45-degree field of view; retinal fundus photograph; 2352 x 1568 pixels: 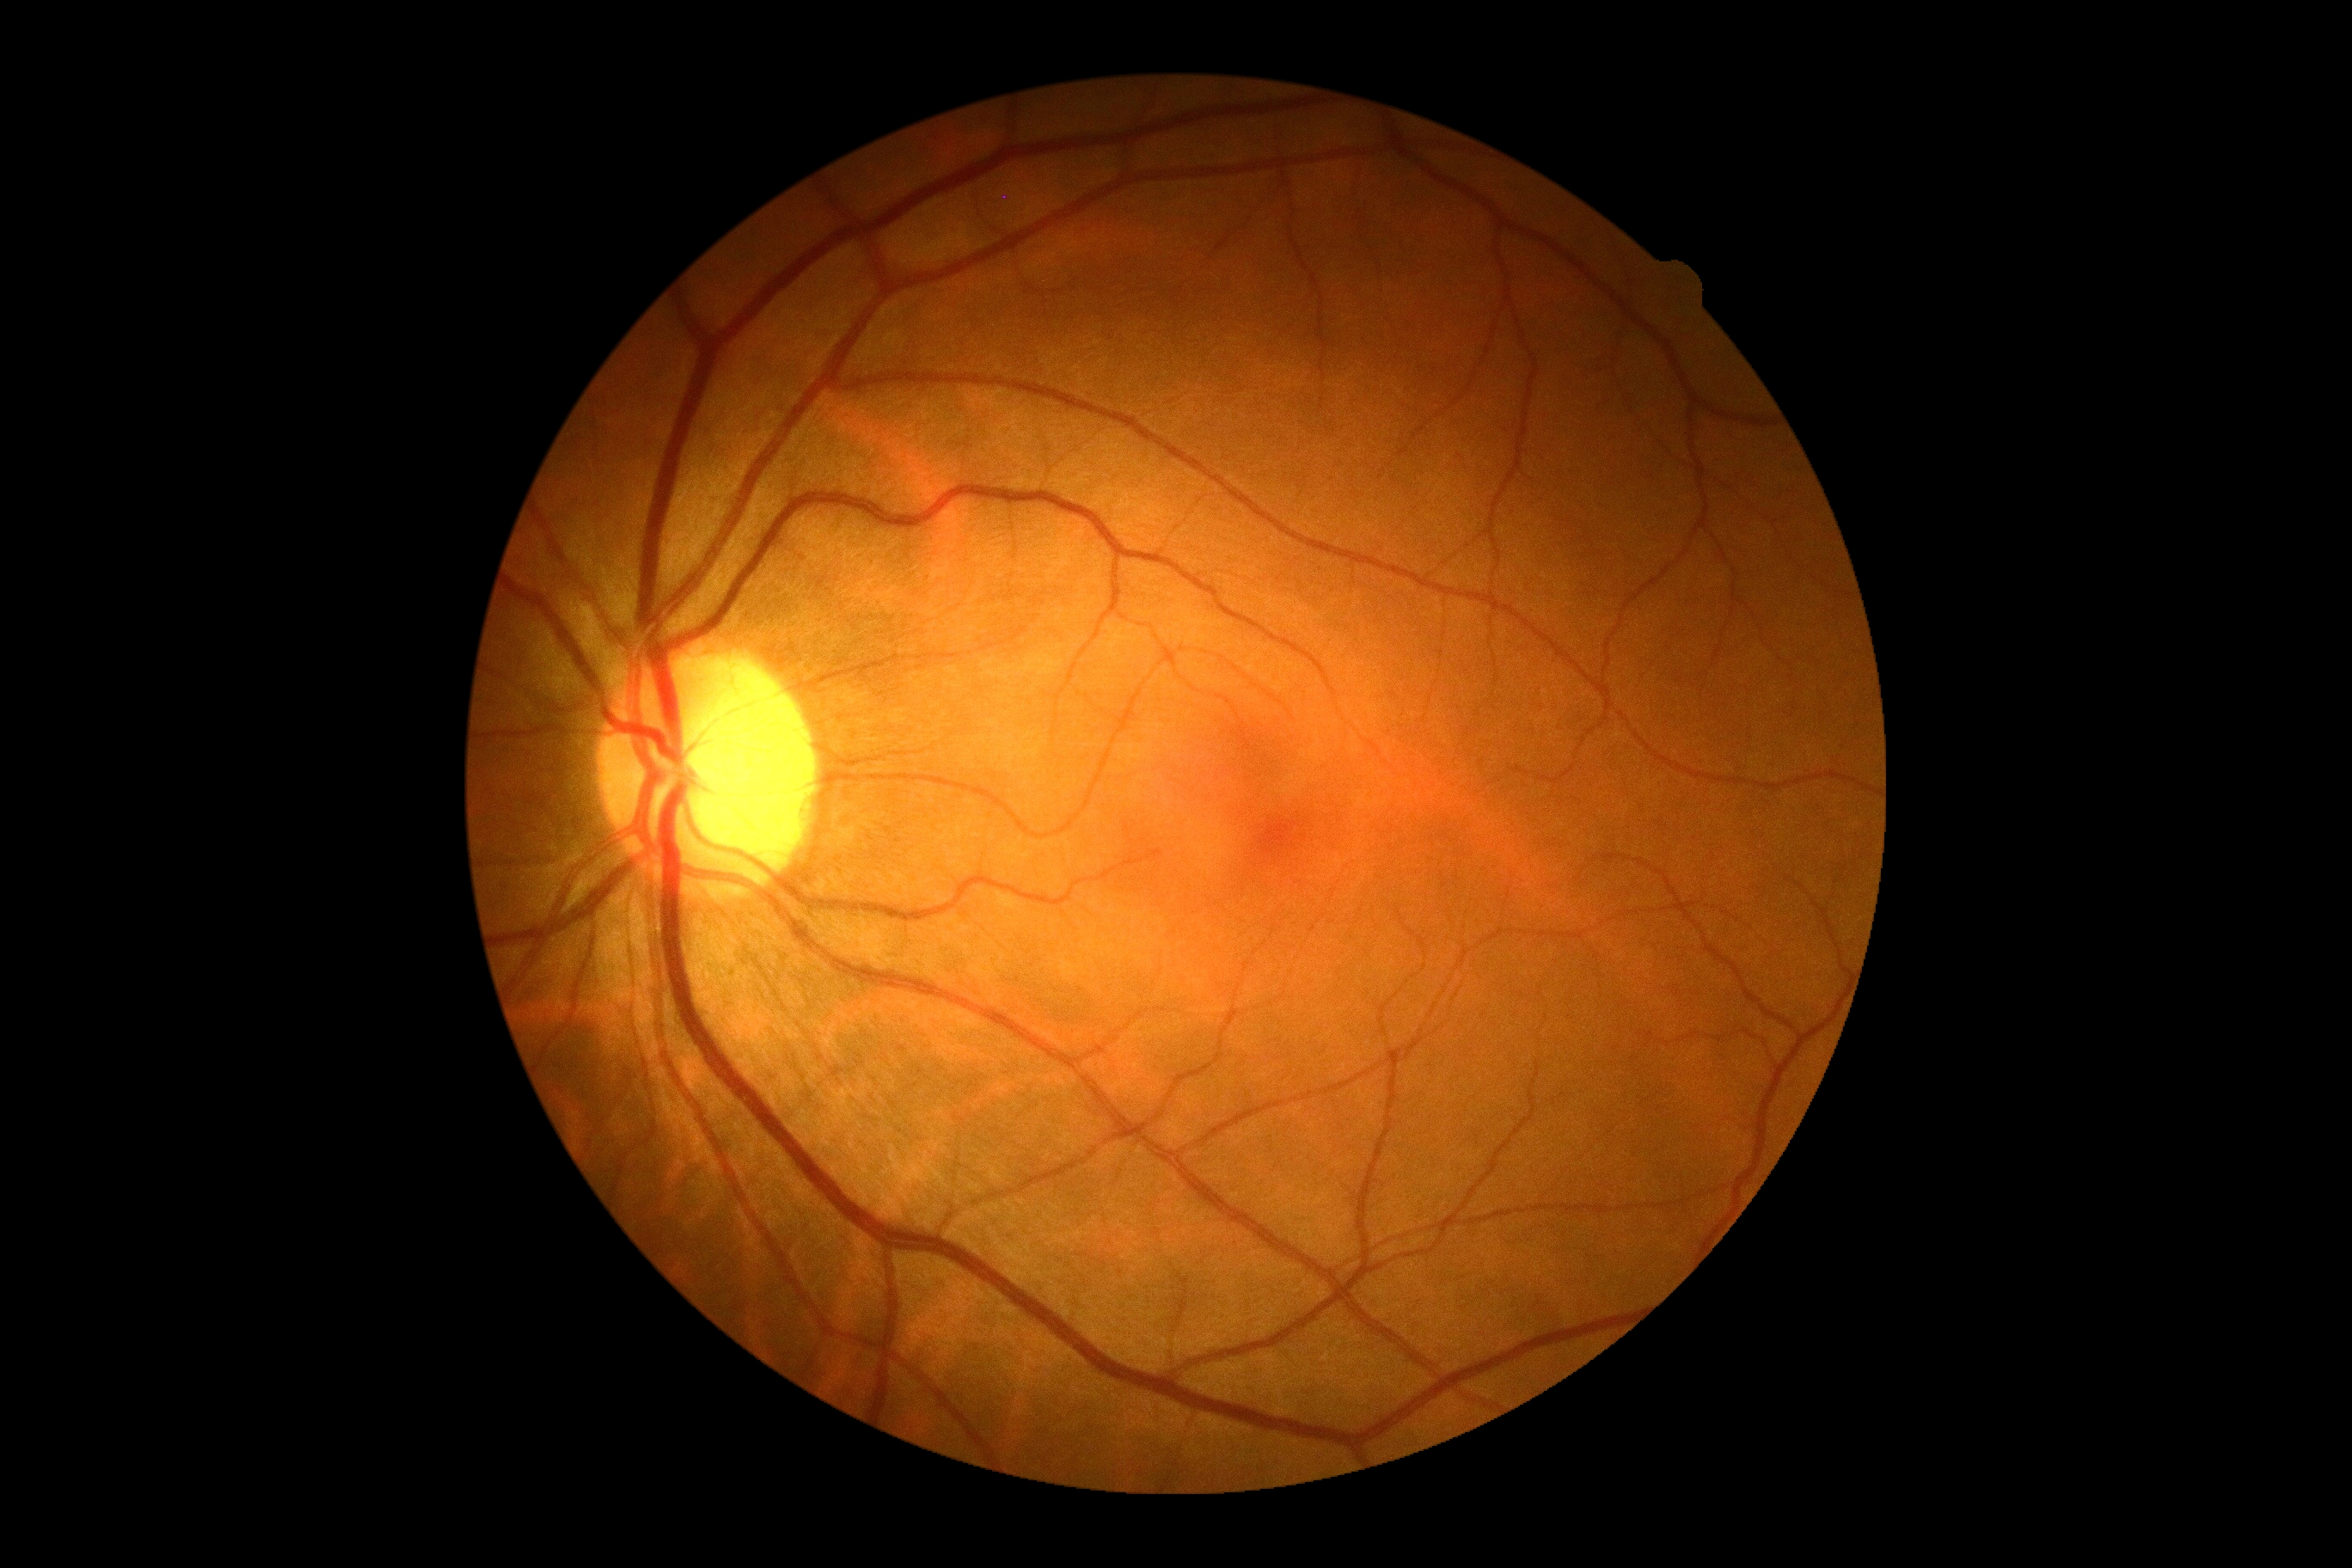 DR stage is grade 0.